Infant wide-field fundus photograph.
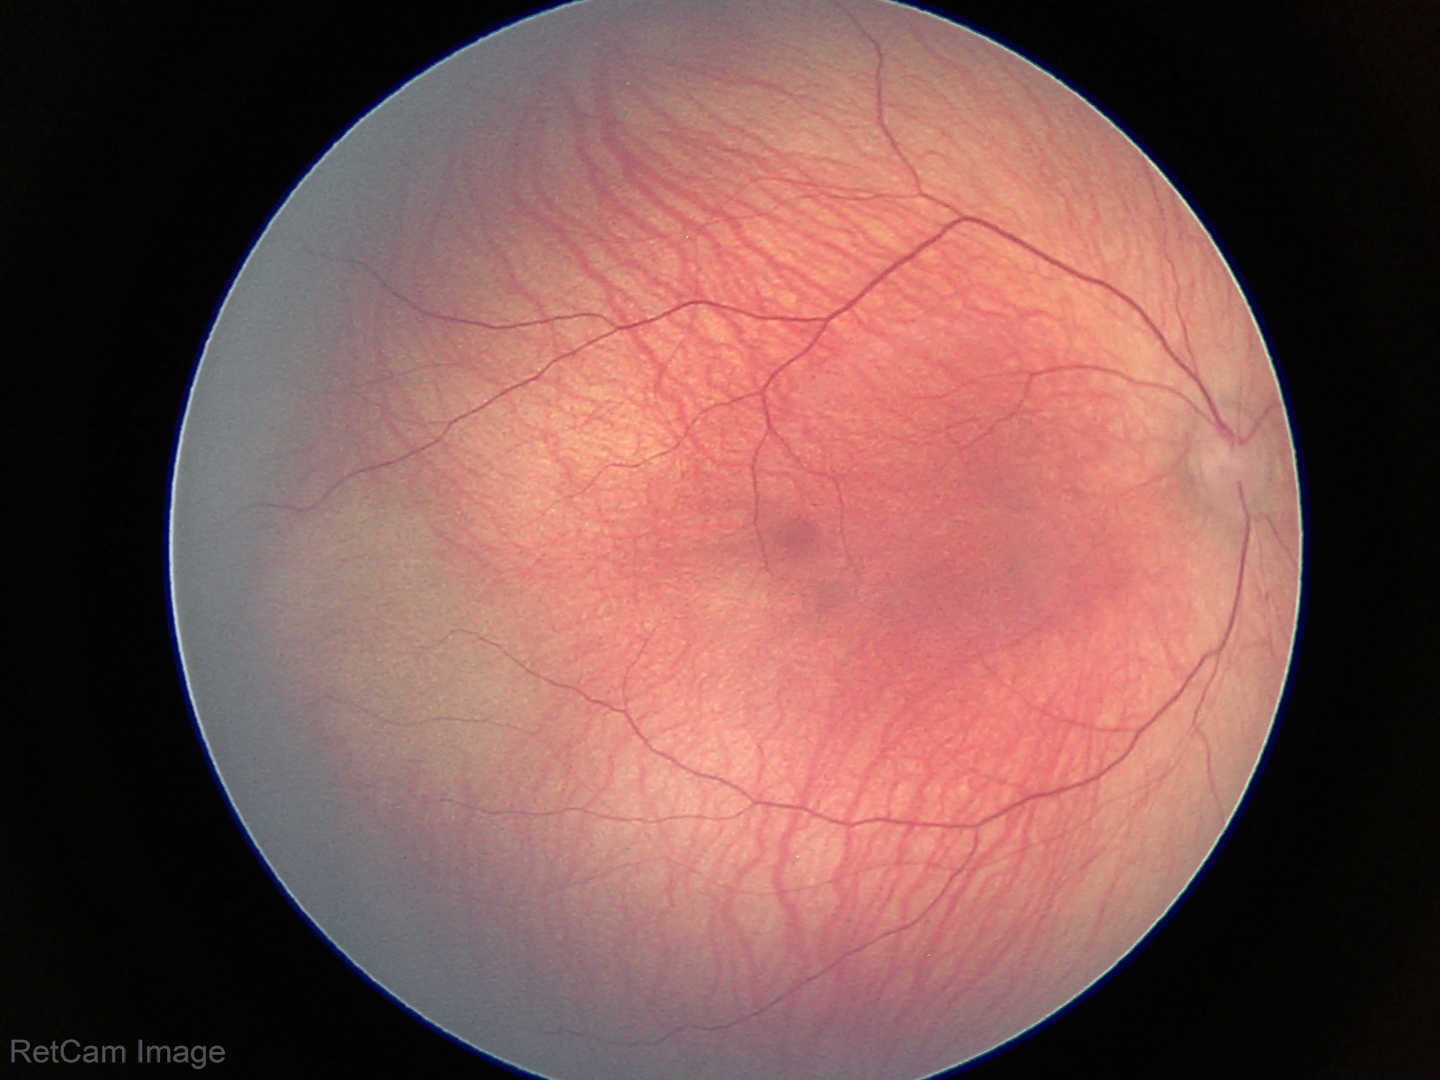 Impression = normal retinal appearance.